Modified Davis classification: 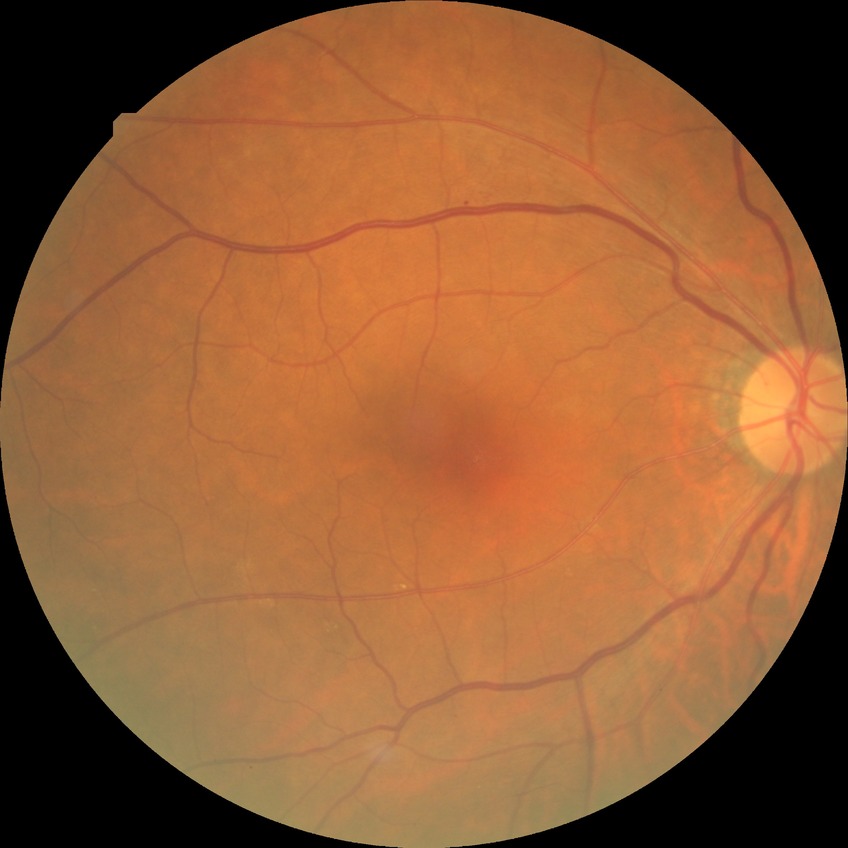 Diabetic retinopathy stage: simple diabetic retinopathy. The retinopathy is classified as non-proliferative diabetic retinopathy.